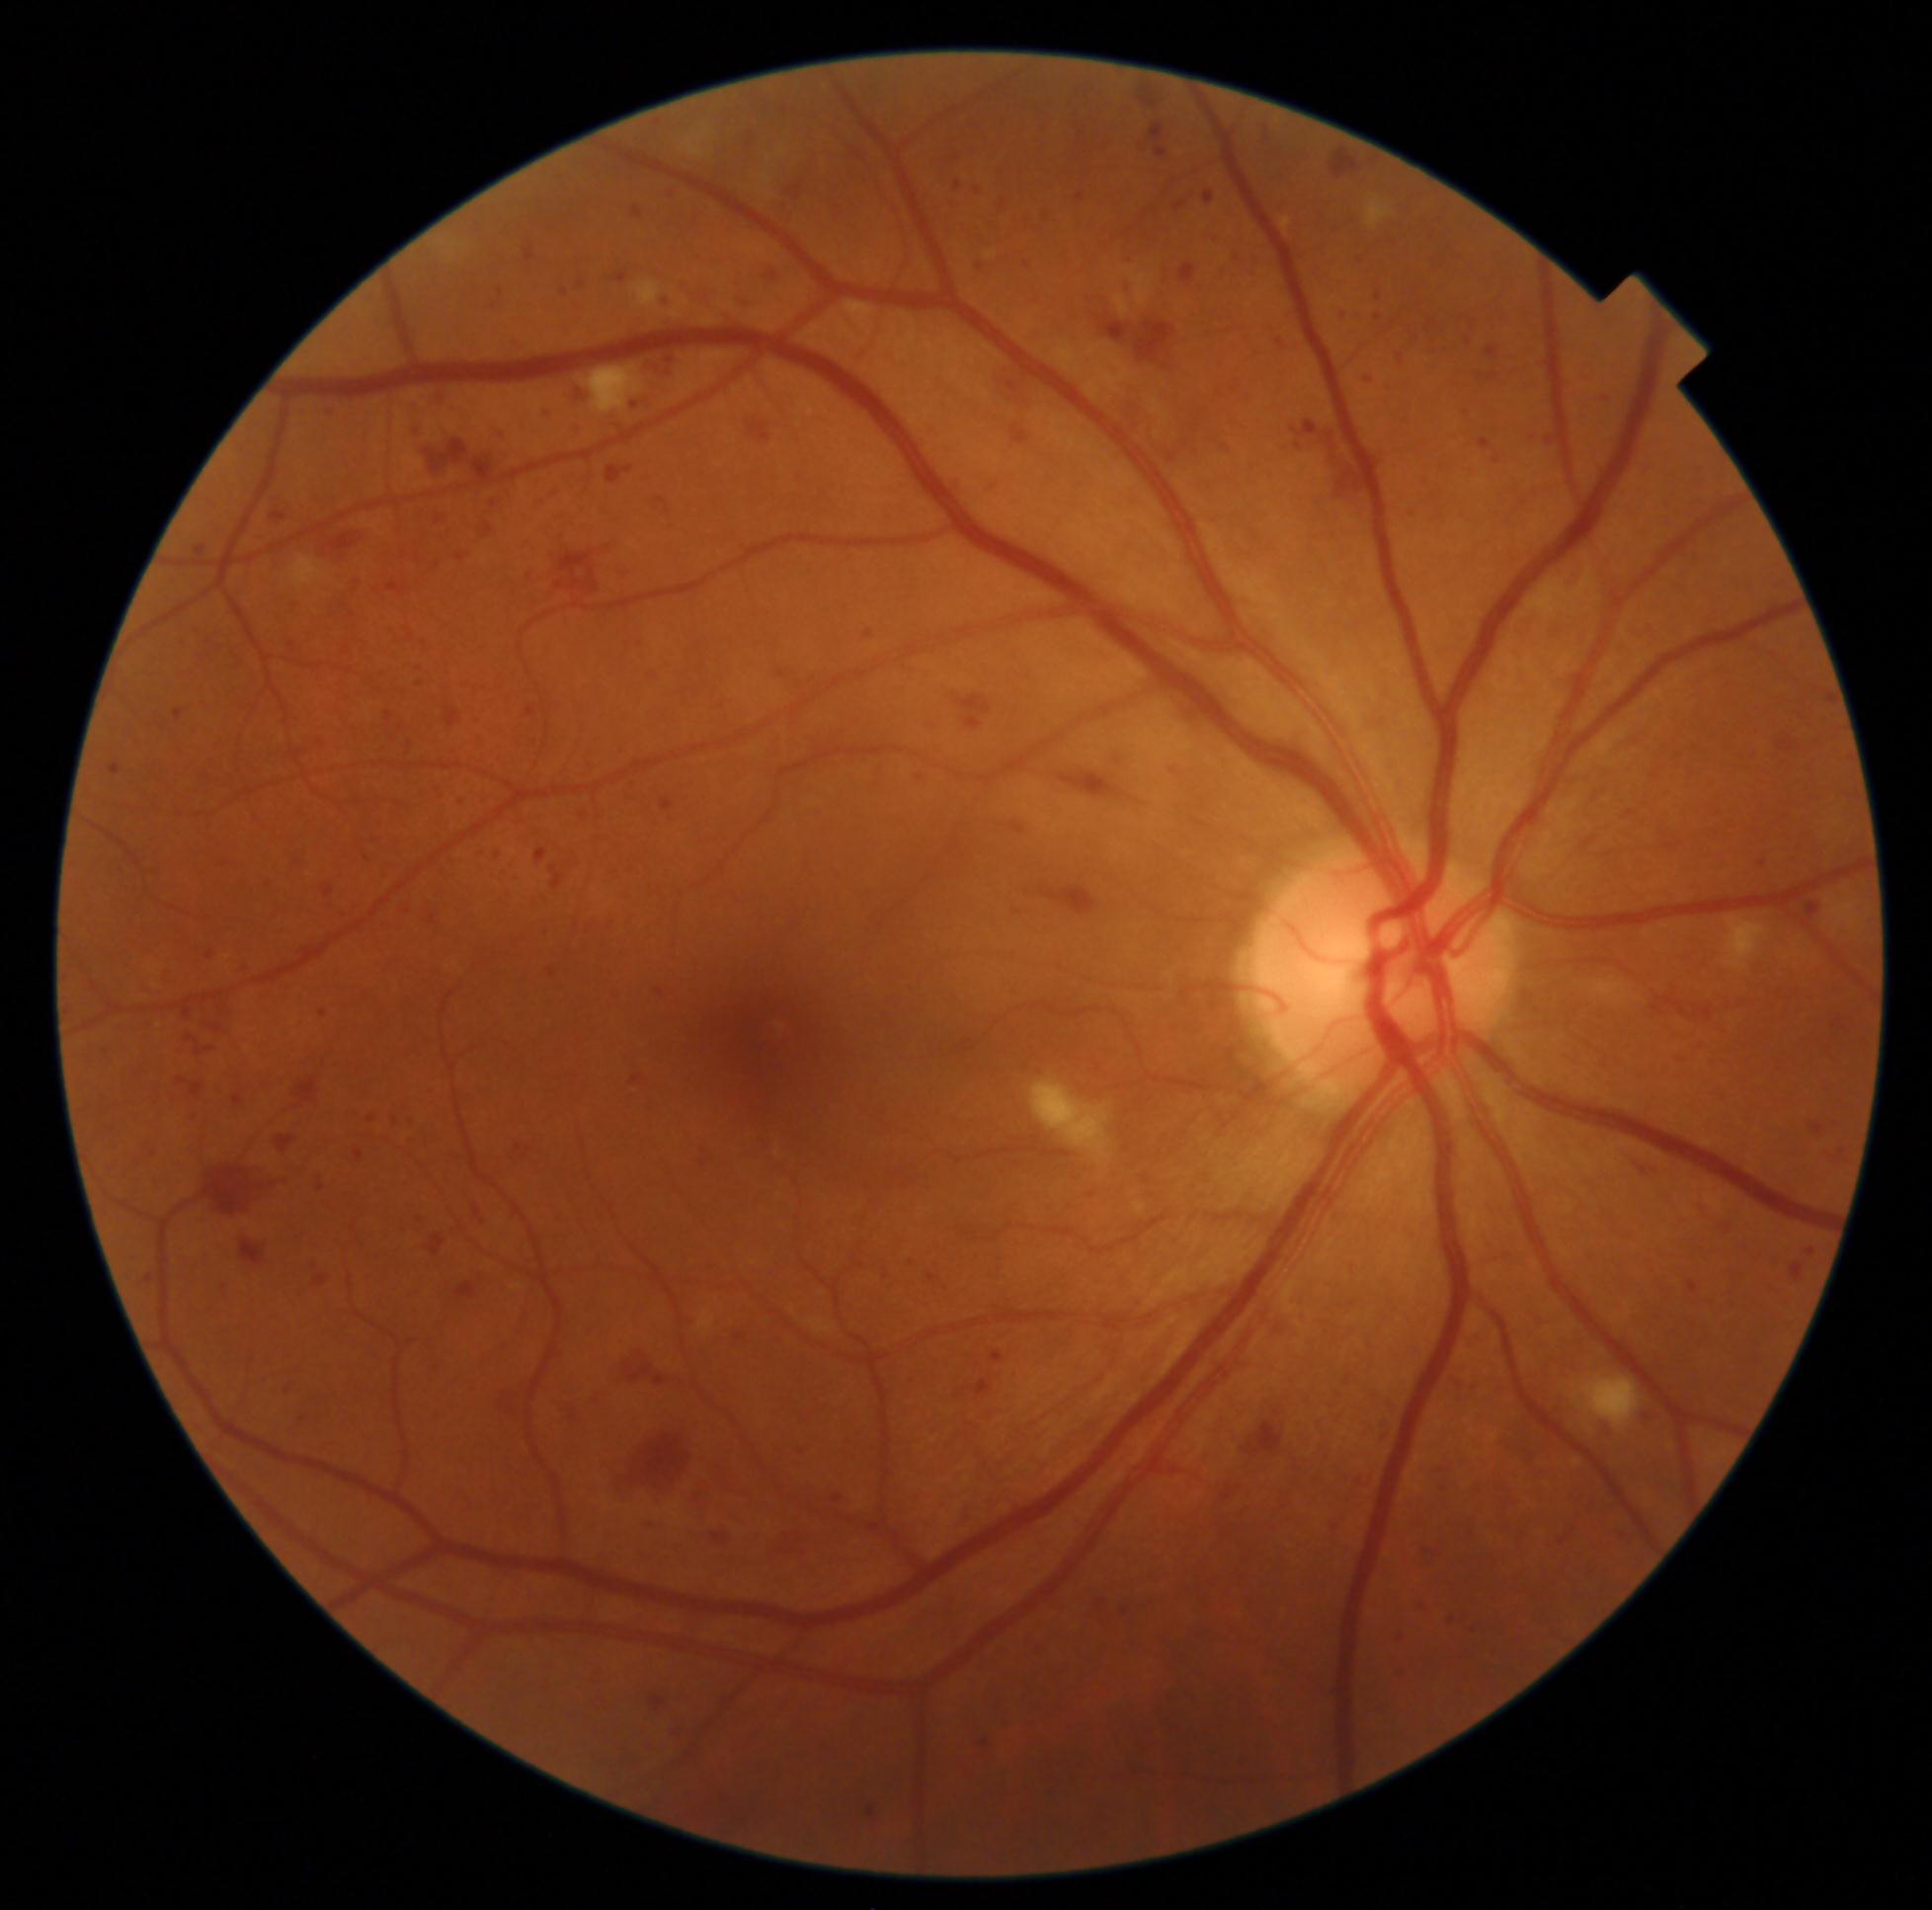

DR is grade 3 (severe NPDR)
Representative lesions:
HEs (partial): BBox(468, 1202, 489, 1228), BBox(1077, 194, 1084, 203), BBox(614, 273, 627, 283), BBox(1521, 432, 1536, 447), BBox(1275, 335, 1289, 348), BBox(179, 1111, 201, 1124), BBox(108, 865, 126, 879), BBox(1286, 417, 1370, 526), BBox(172, 708, 188, 728), BBox(361, 1113, 380, 1133), BBox(782, 180, 811, 203), BBox(459, 1270, 491, 1304), BBox(1156, 148, 1167, 158), BBox(1330, 146, 1383, 187), BBox(711, 1527, 734, 1547), BBox(148, 1149, 161, 1164), BBox(95, 1047, 117, 1063), BBox(1121, 257, 1134, 269)
Small HEs approximately at x=564, y=293, x=366, y=858